45° field of view, 2352x1568: 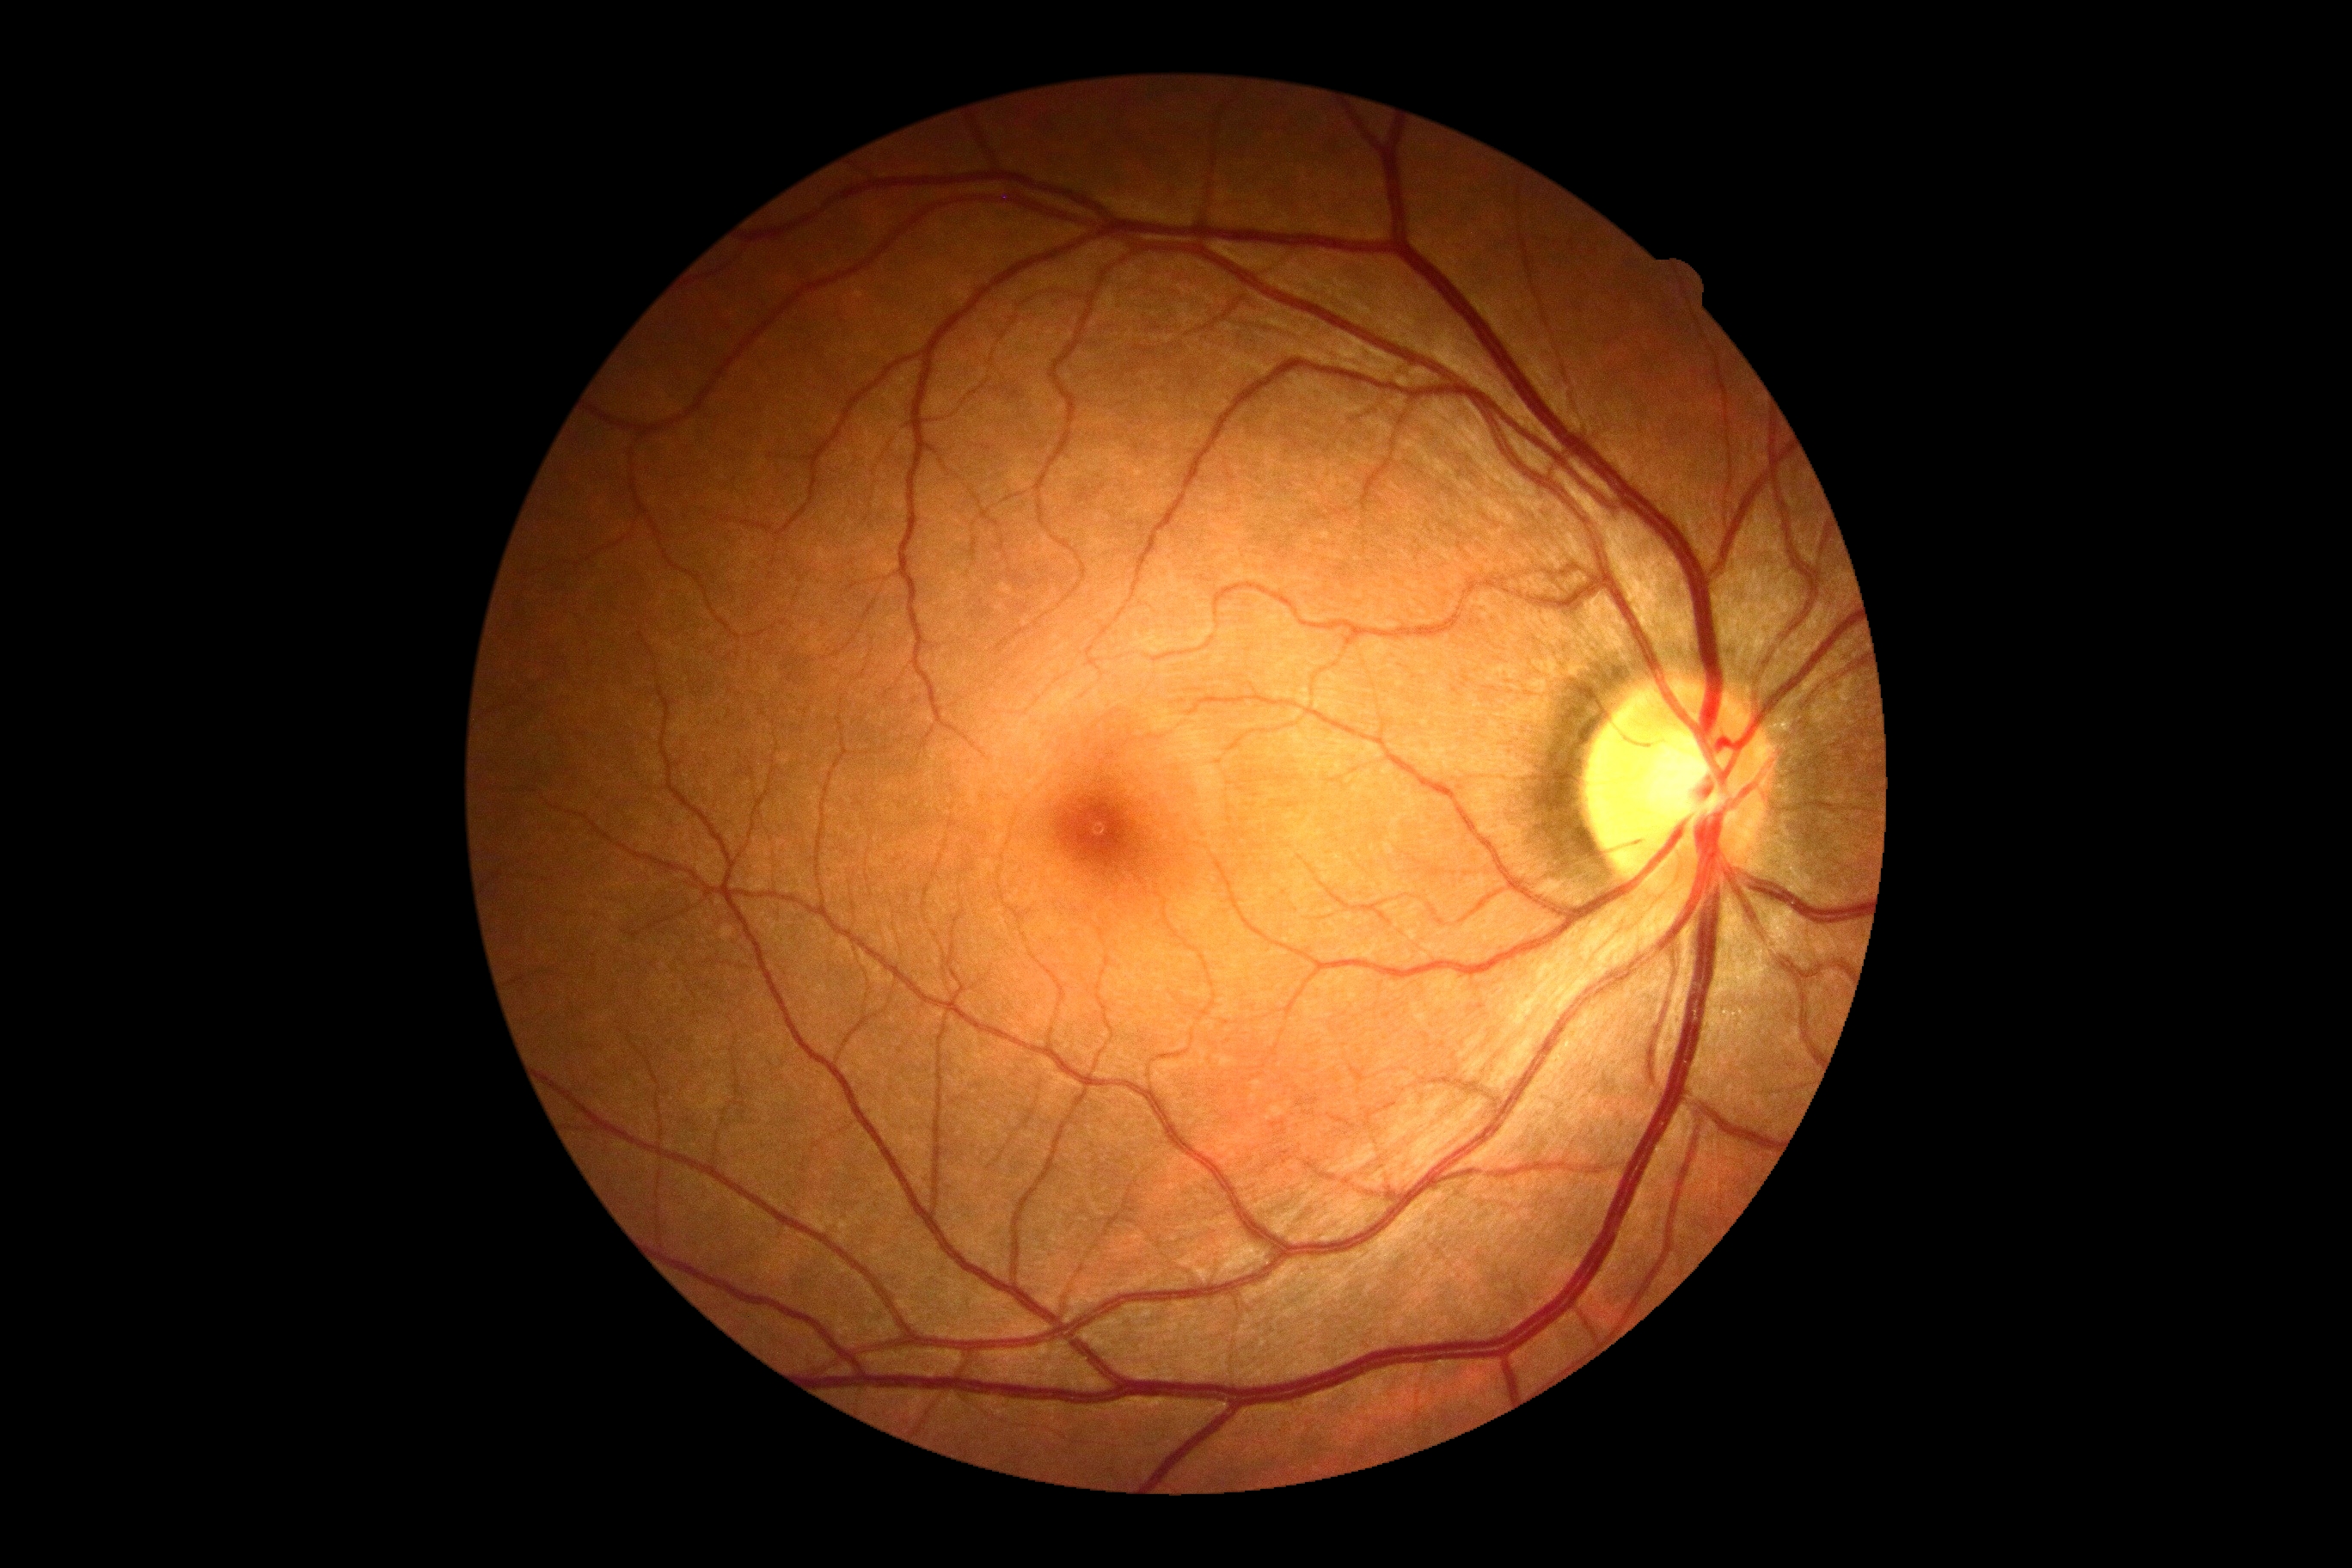

{"dr_grade": "0 (no apparent retinopathy)"}